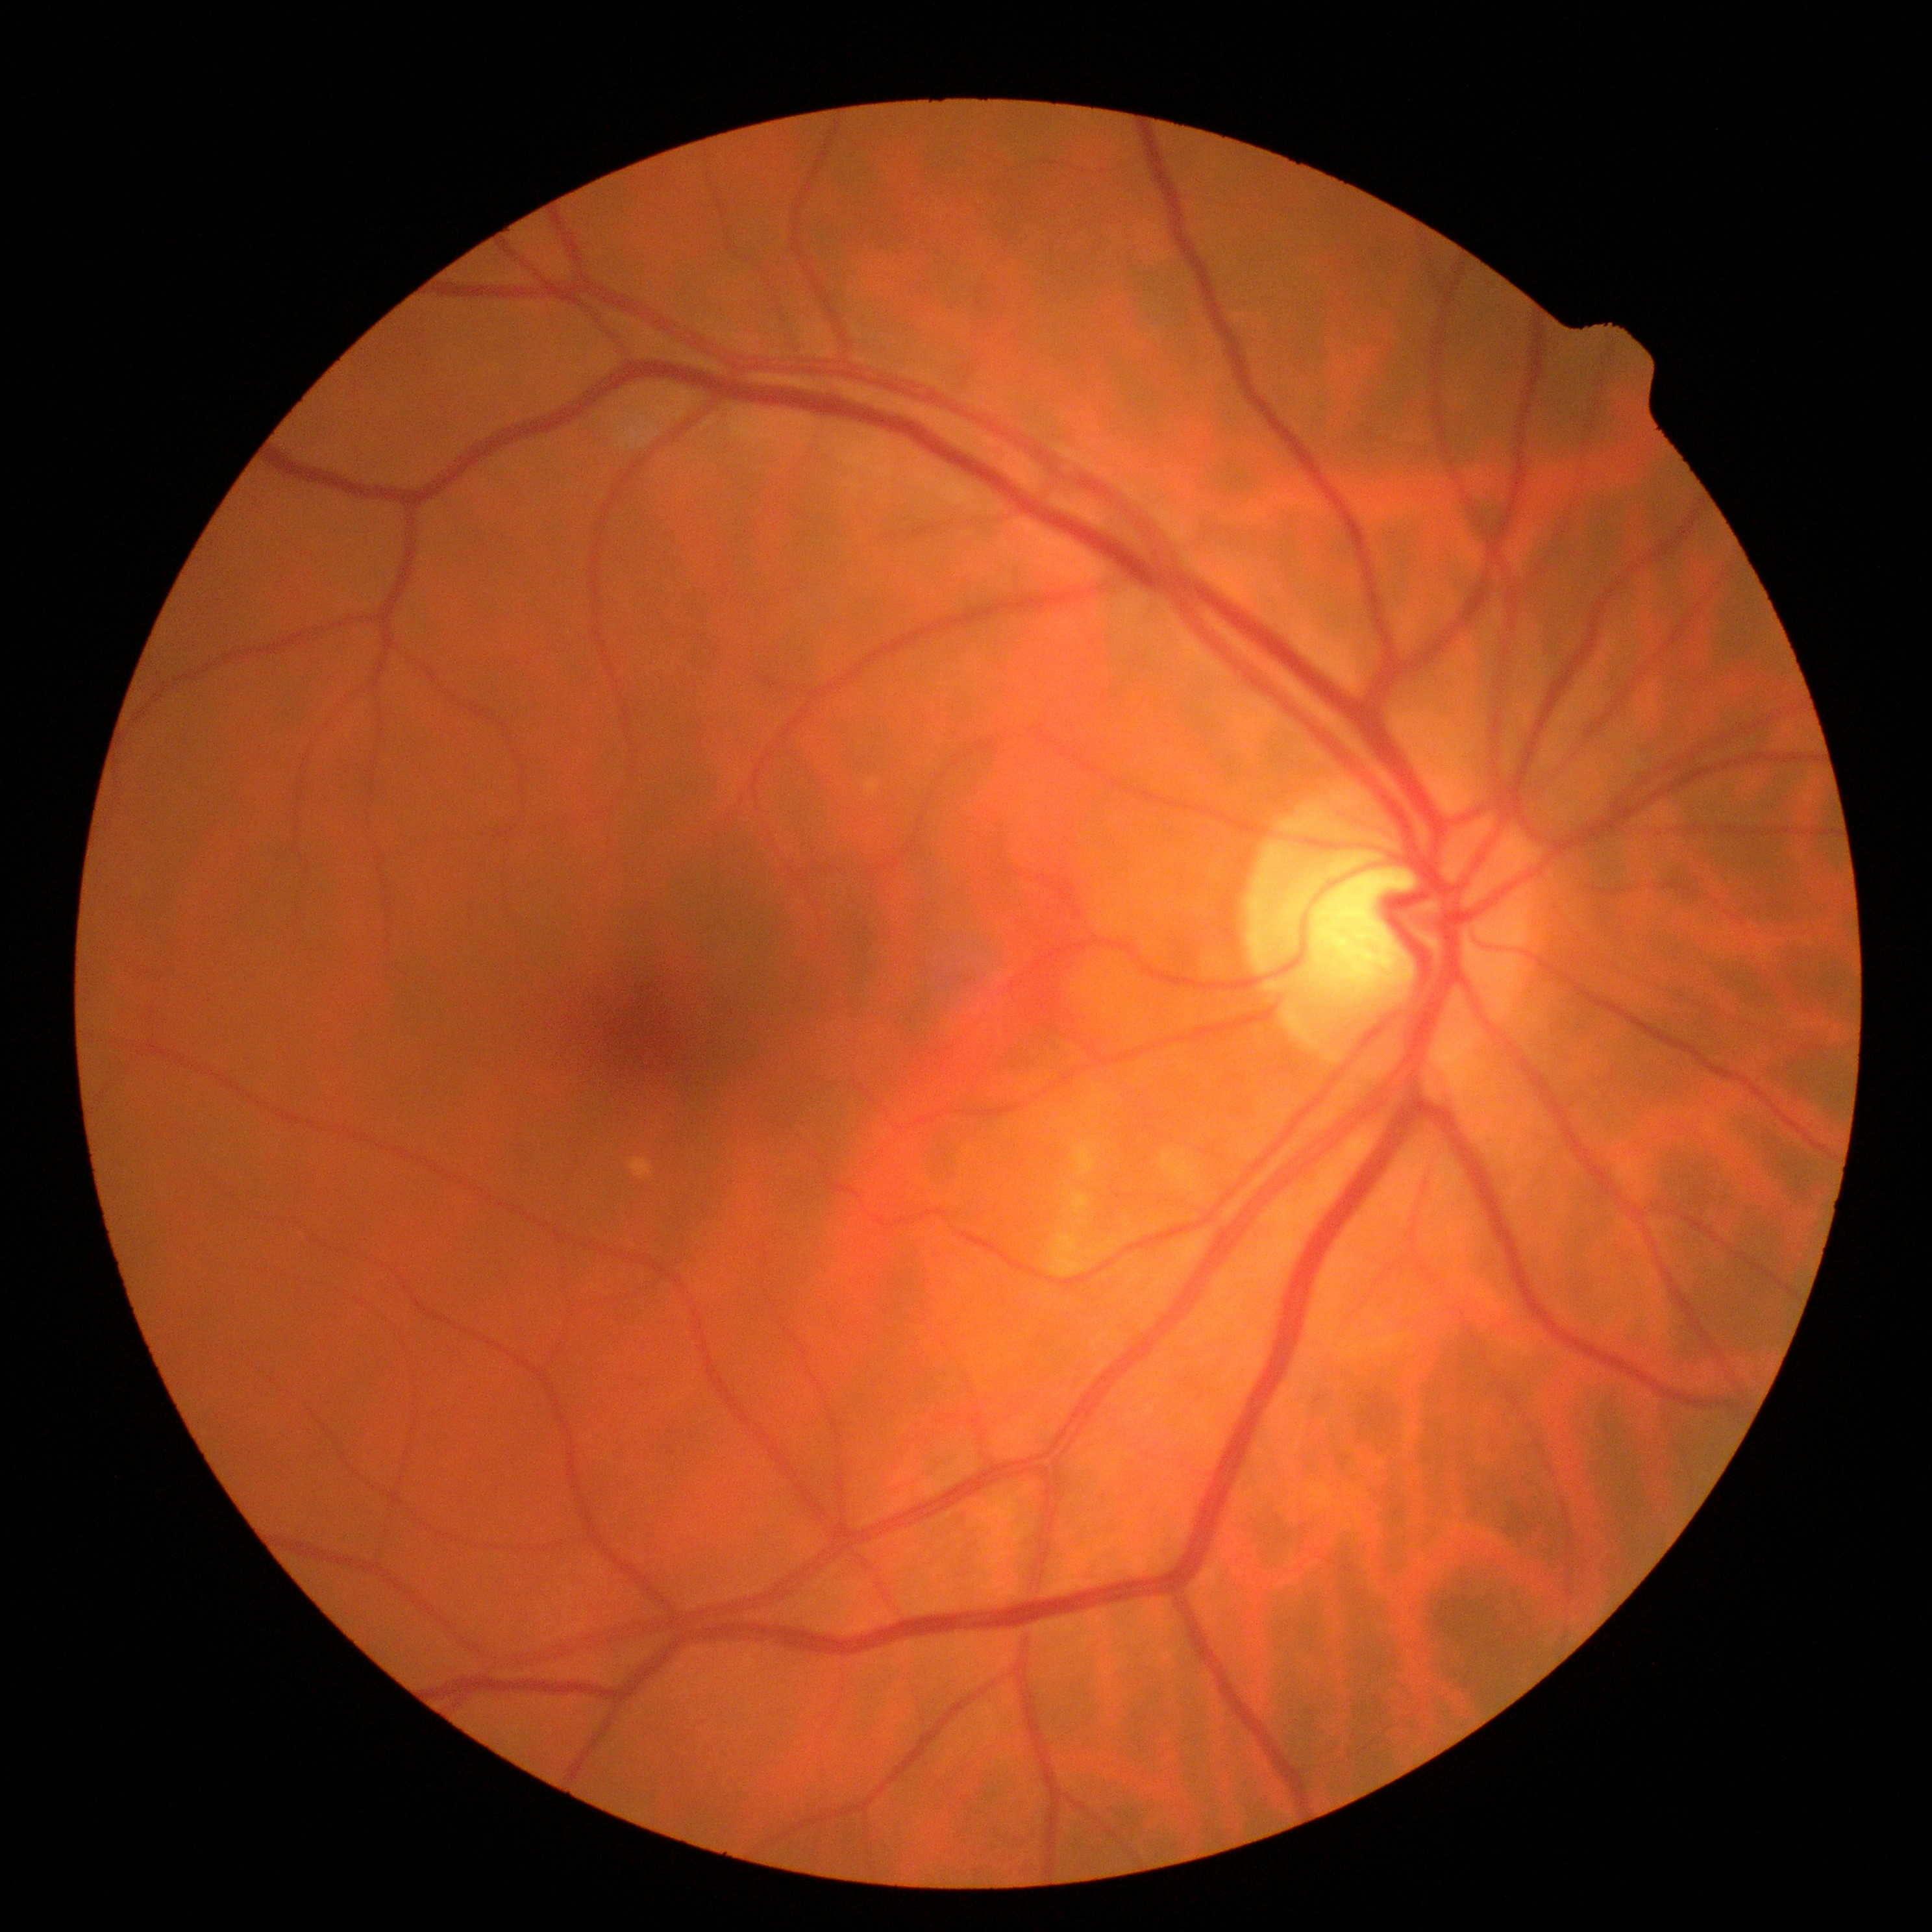 DR impression: no apparent DR, diabetic retinopathy (DR): no apparent diabetic retinopathy (grade 0).